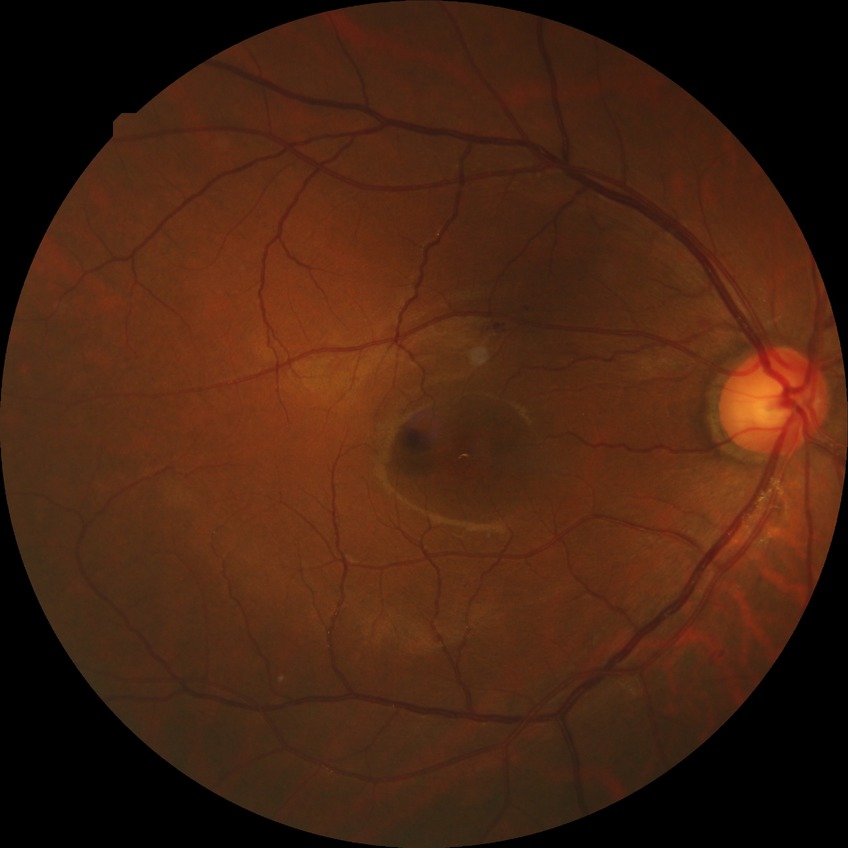 Davis grading is simple diabetic retinopathy.